Wide-field fundus photograph of an infant:
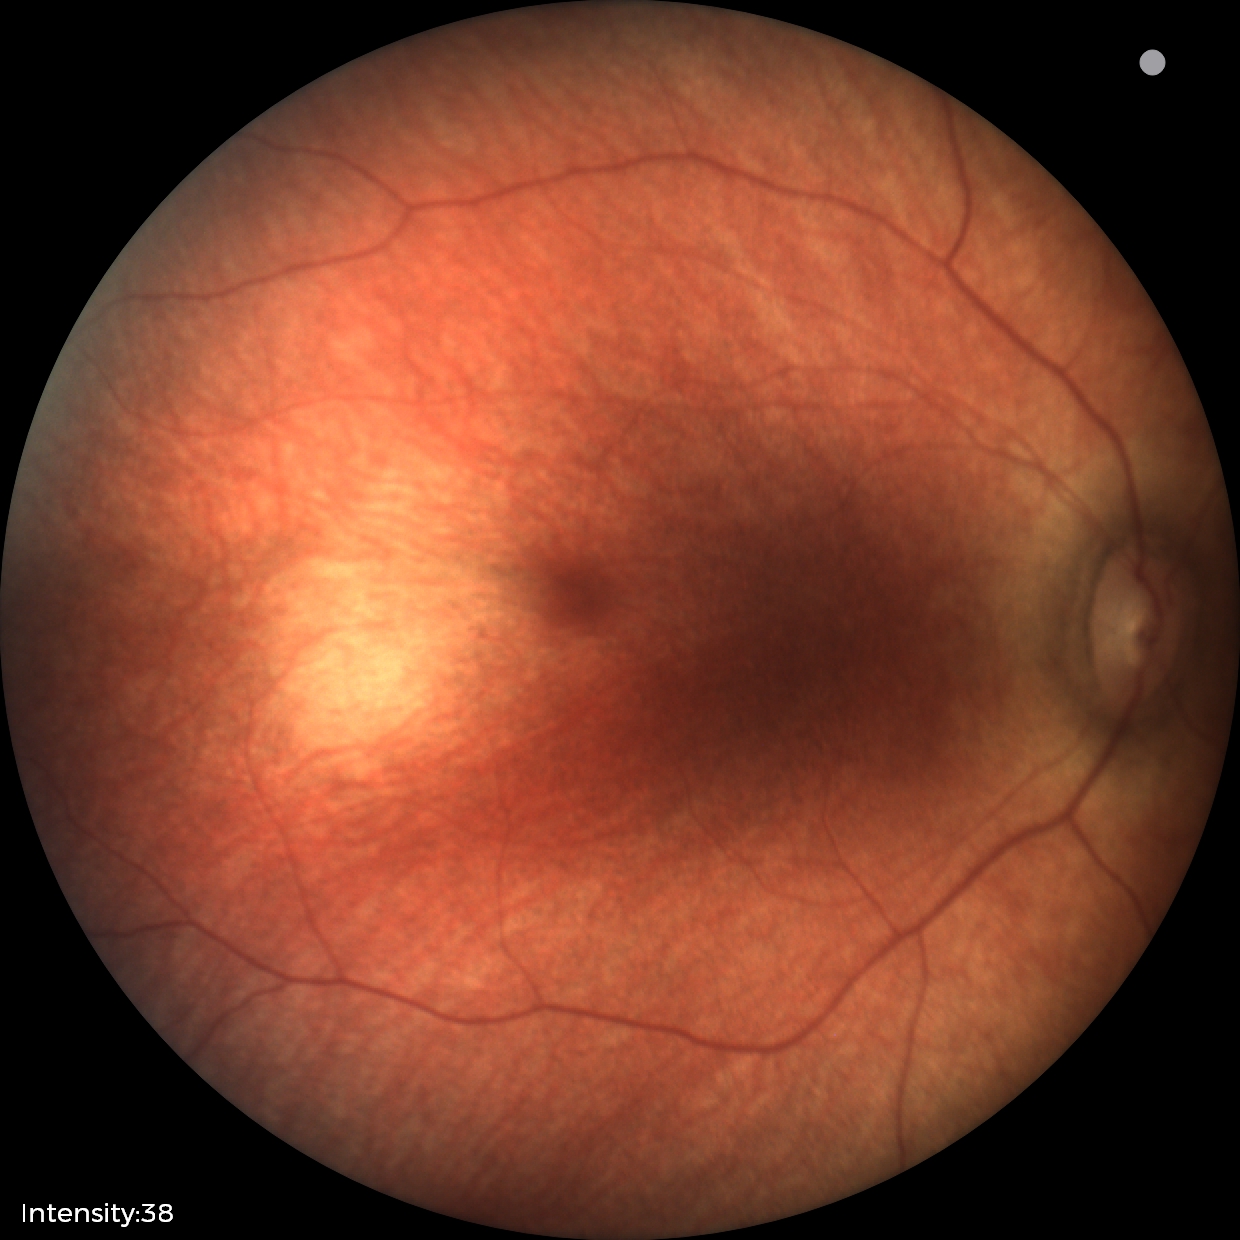

Impression: no abnormalities.